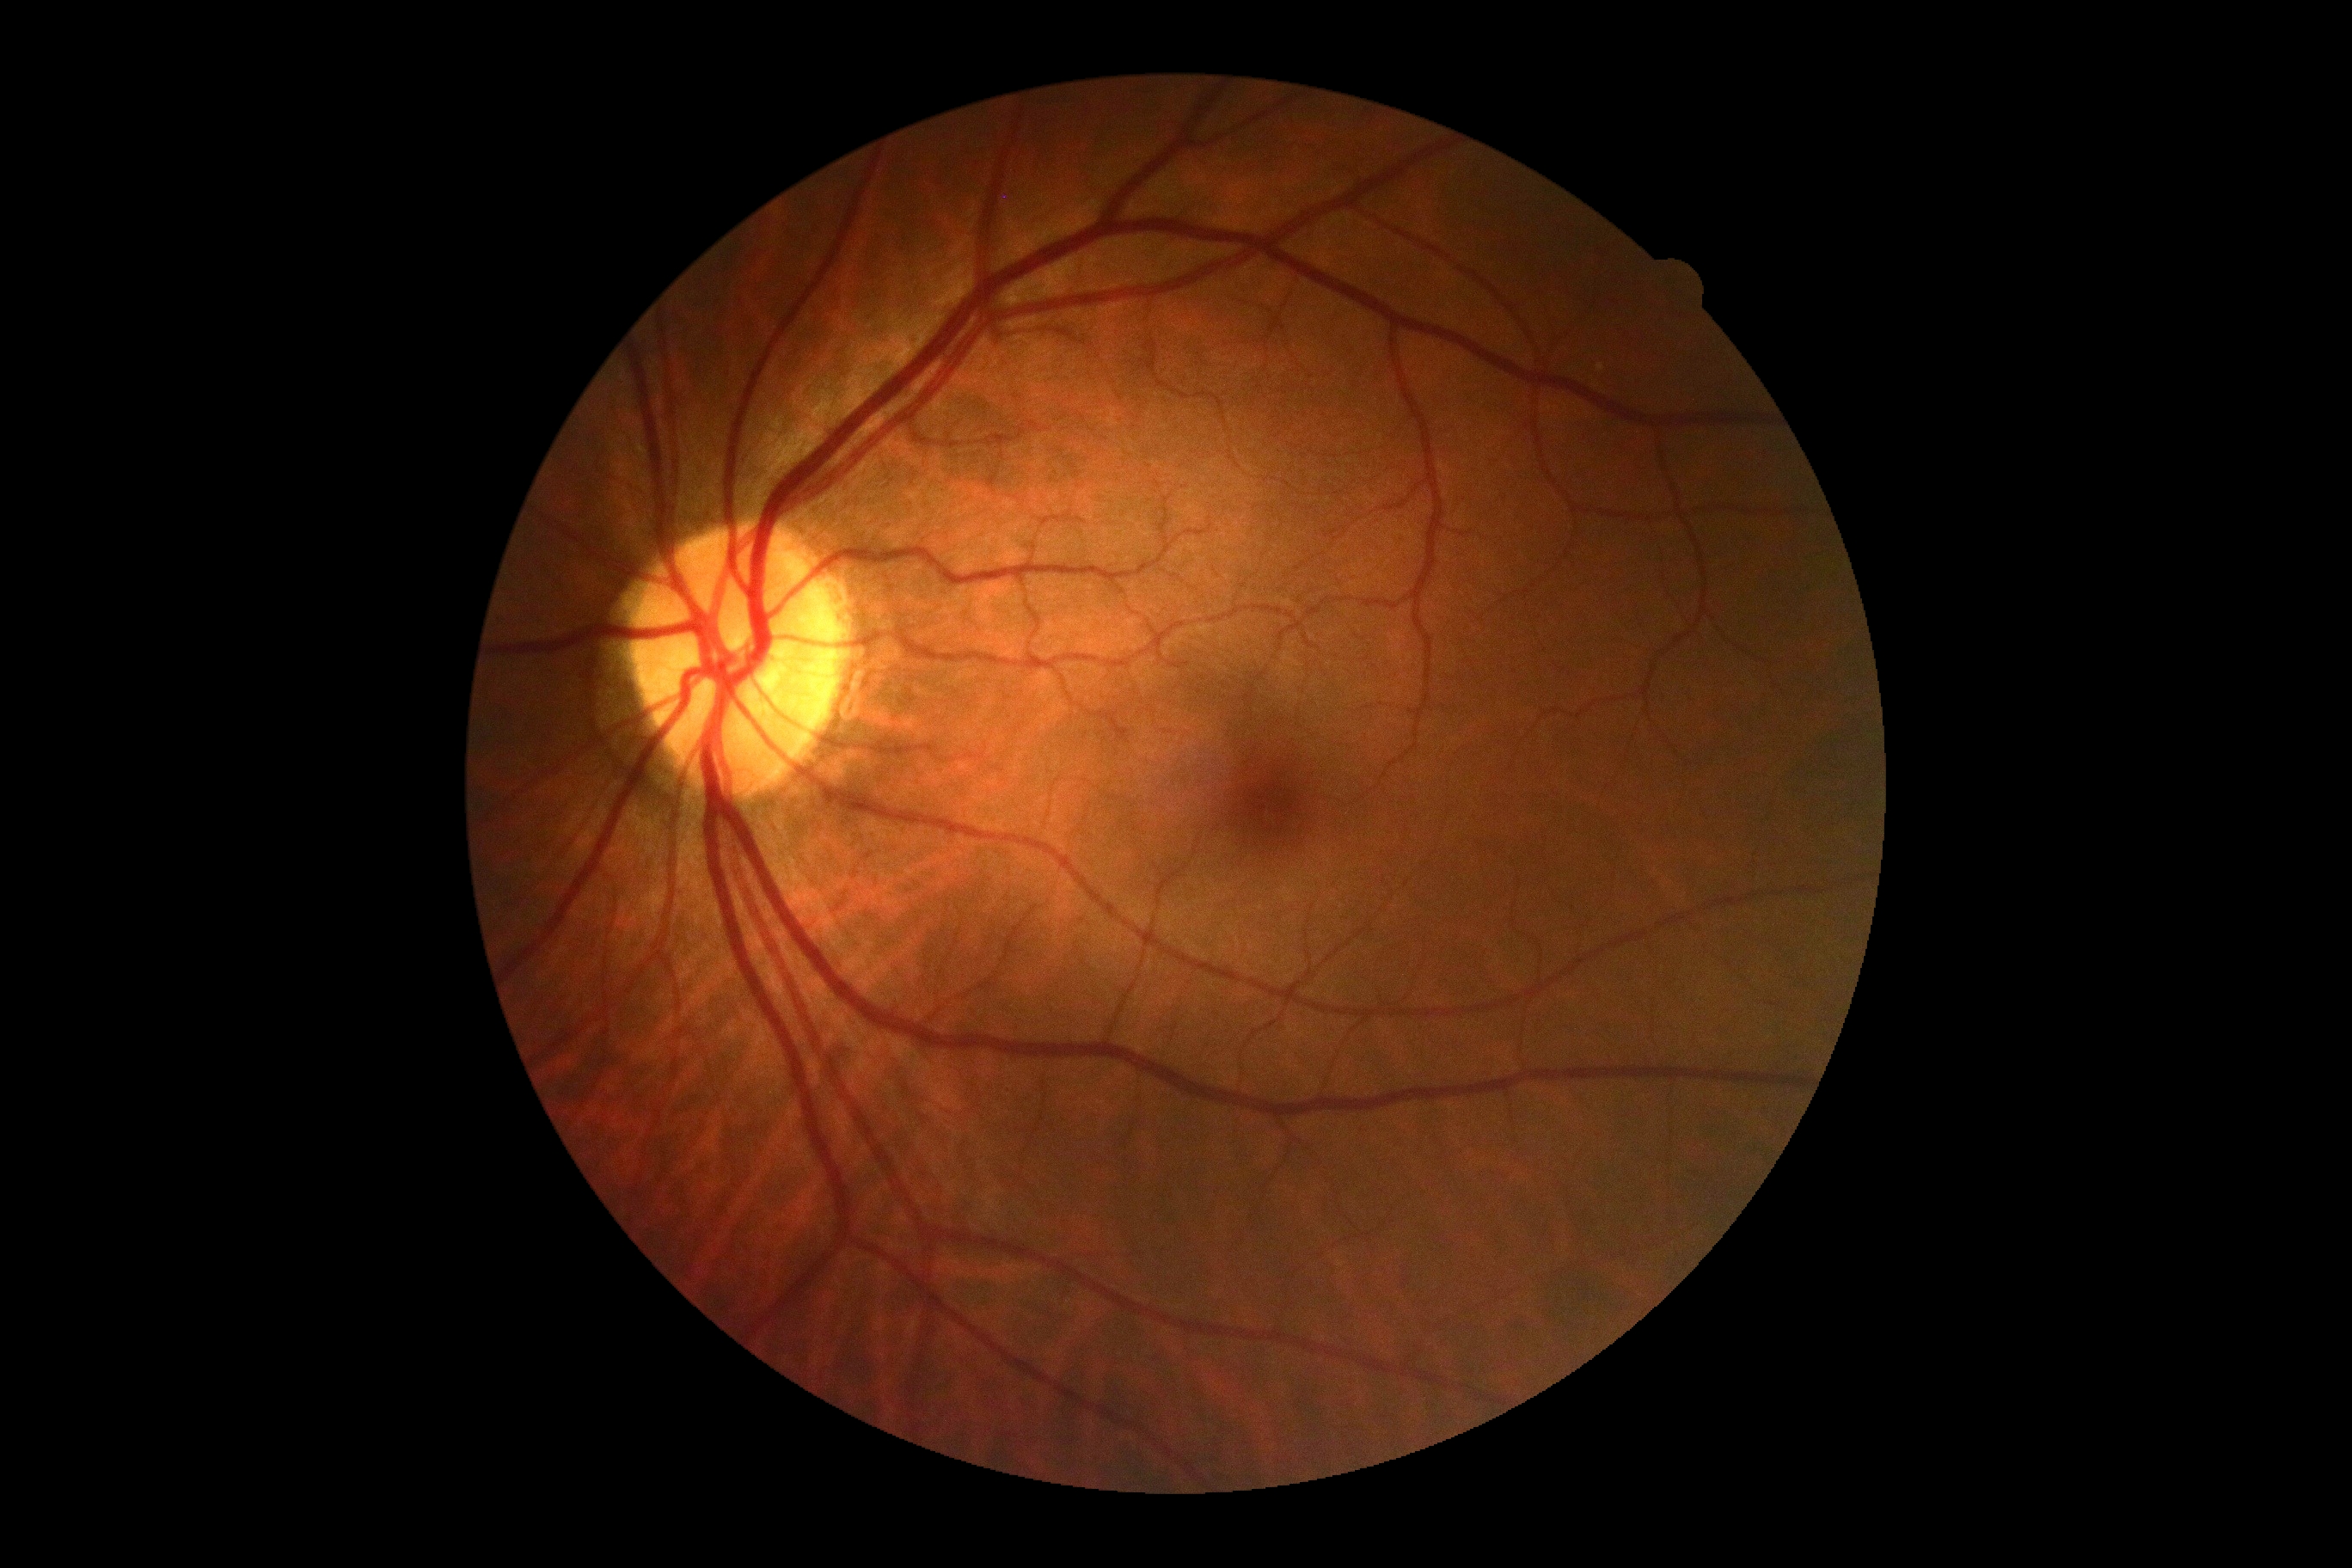 No apparent diabetic retinopathy.
DR severity is grade 0 (no apparent retinopathy).